Infant wide-field fundus photograph
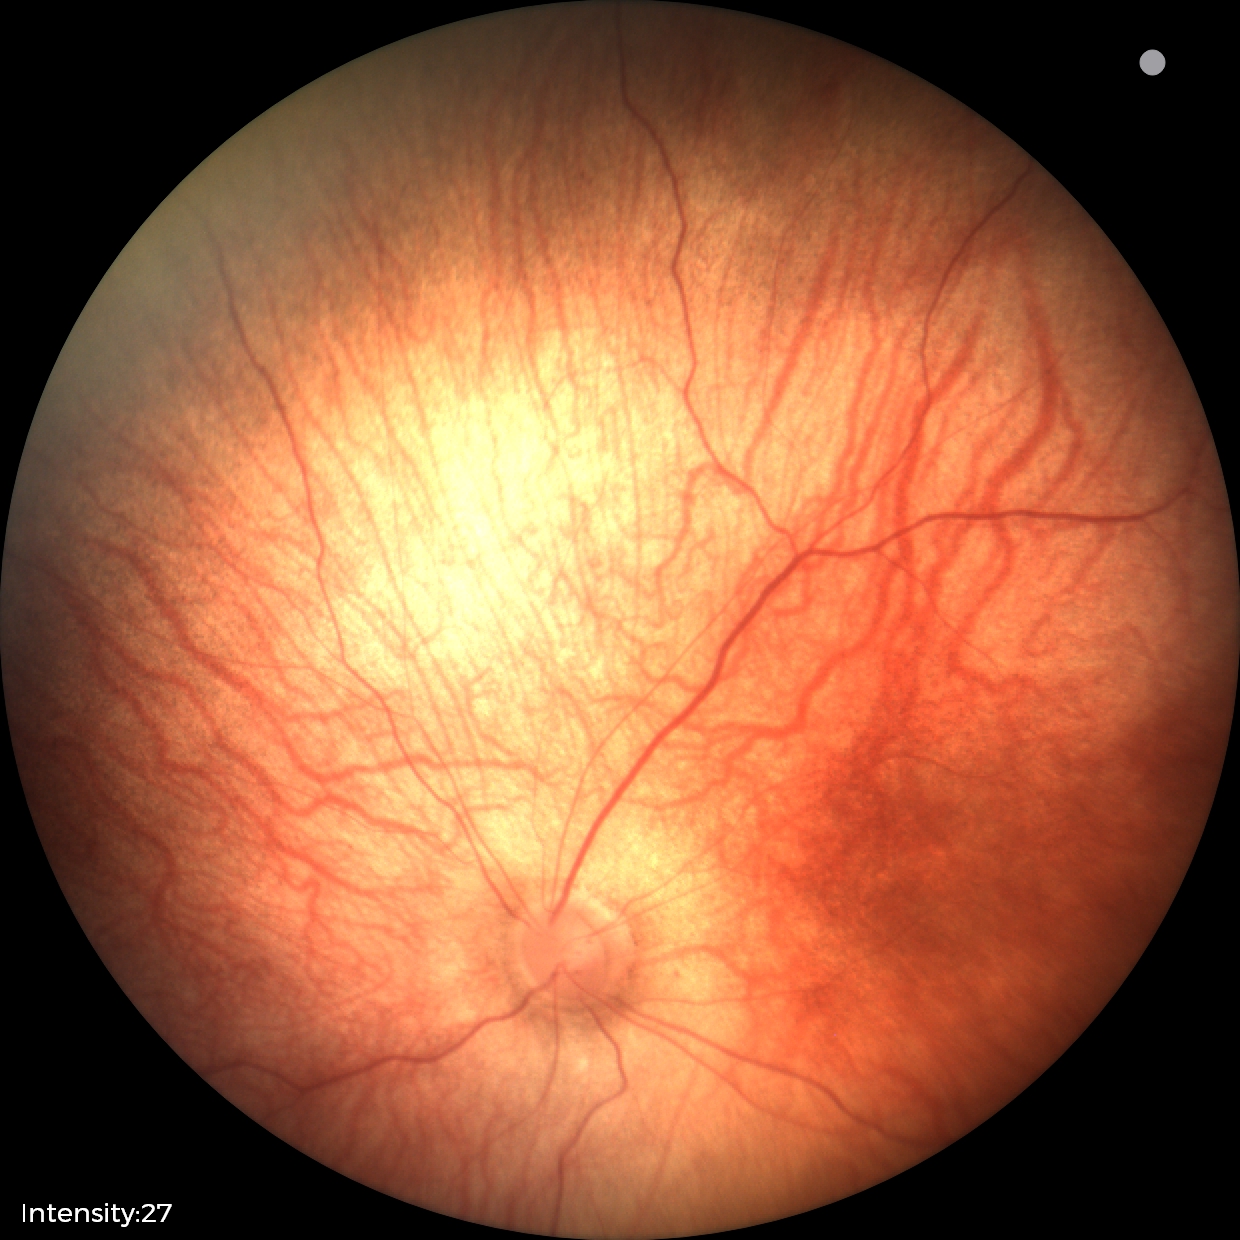 Impression: normal retinal appearance.